Wide-field fundus photograph from neonatal ROP screening
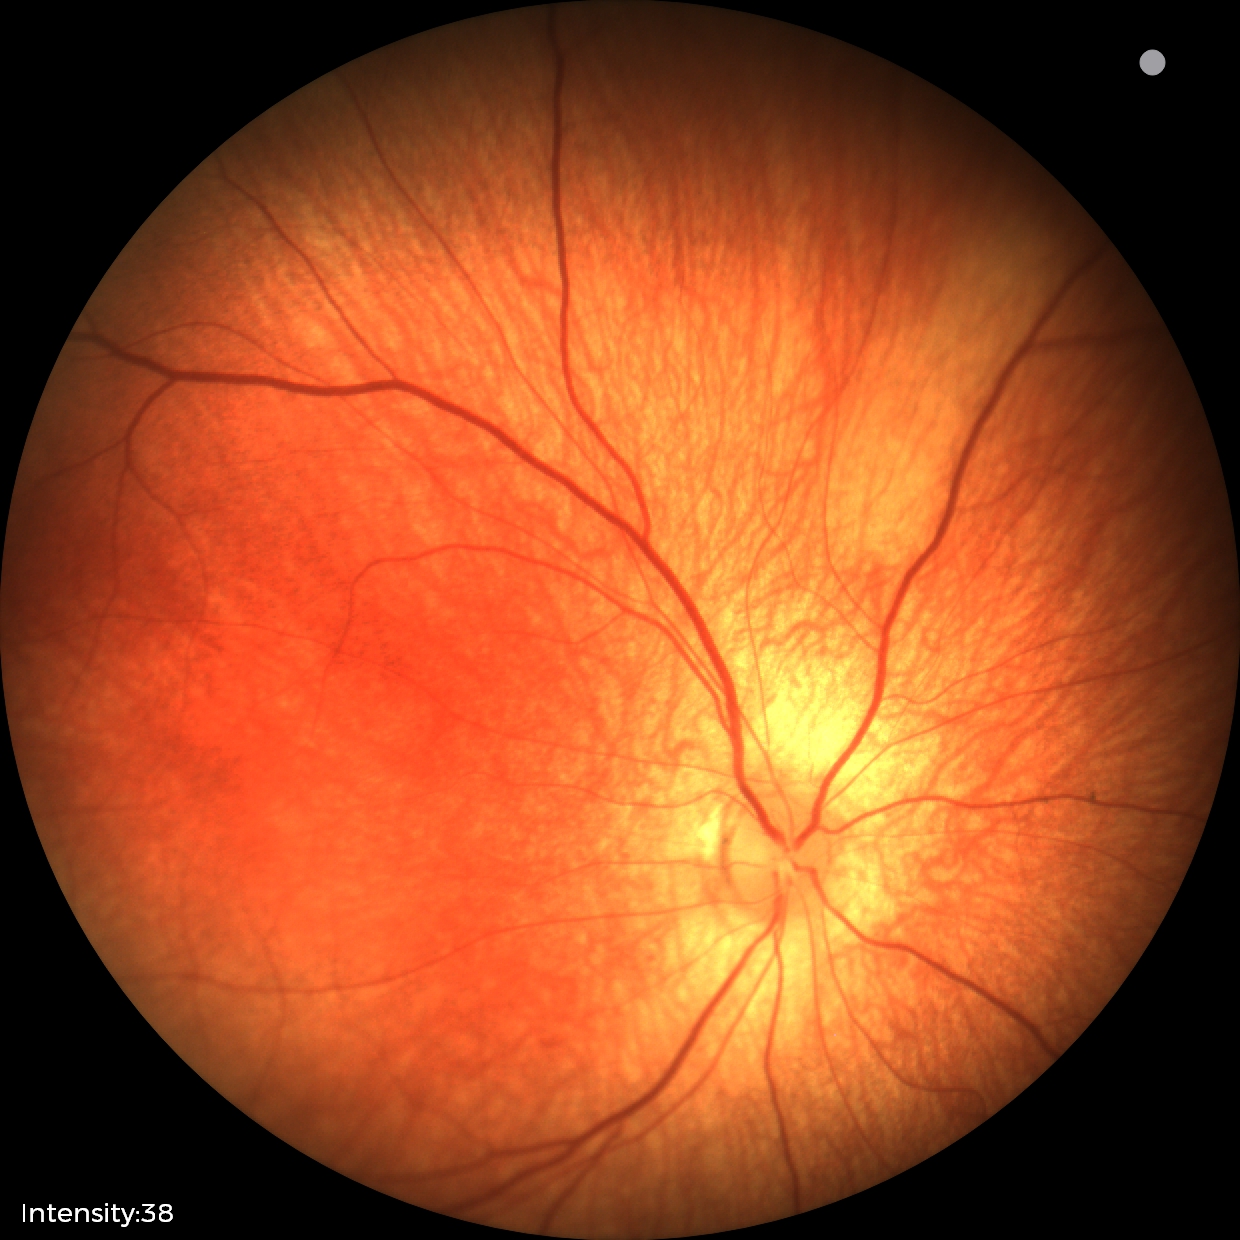

Normal screening examination.